Retinal fundus photograph. NIDEK AFC-230.
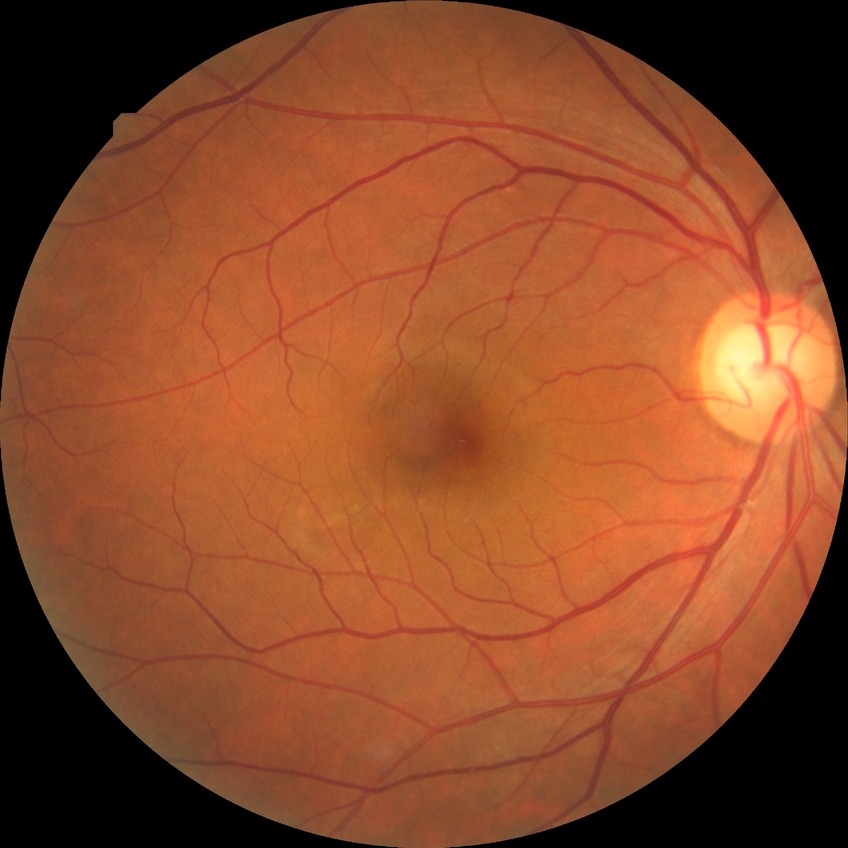

Modified Davis grading: no diabetic retinopathy.